640x480px; camera: Clarity RetCam 3 (130° FOV); infant wide-field retinal image: 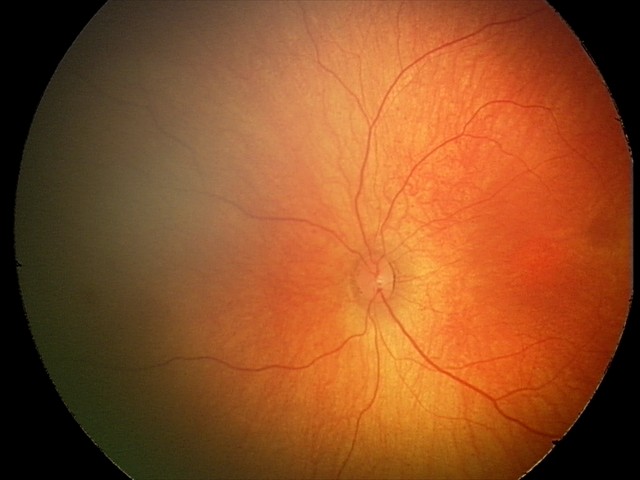

Screening: physiological retinal finding.